Age 49 · 2212 by 1661 pixels · 30° FOV · undilated pupil · fundus photo — 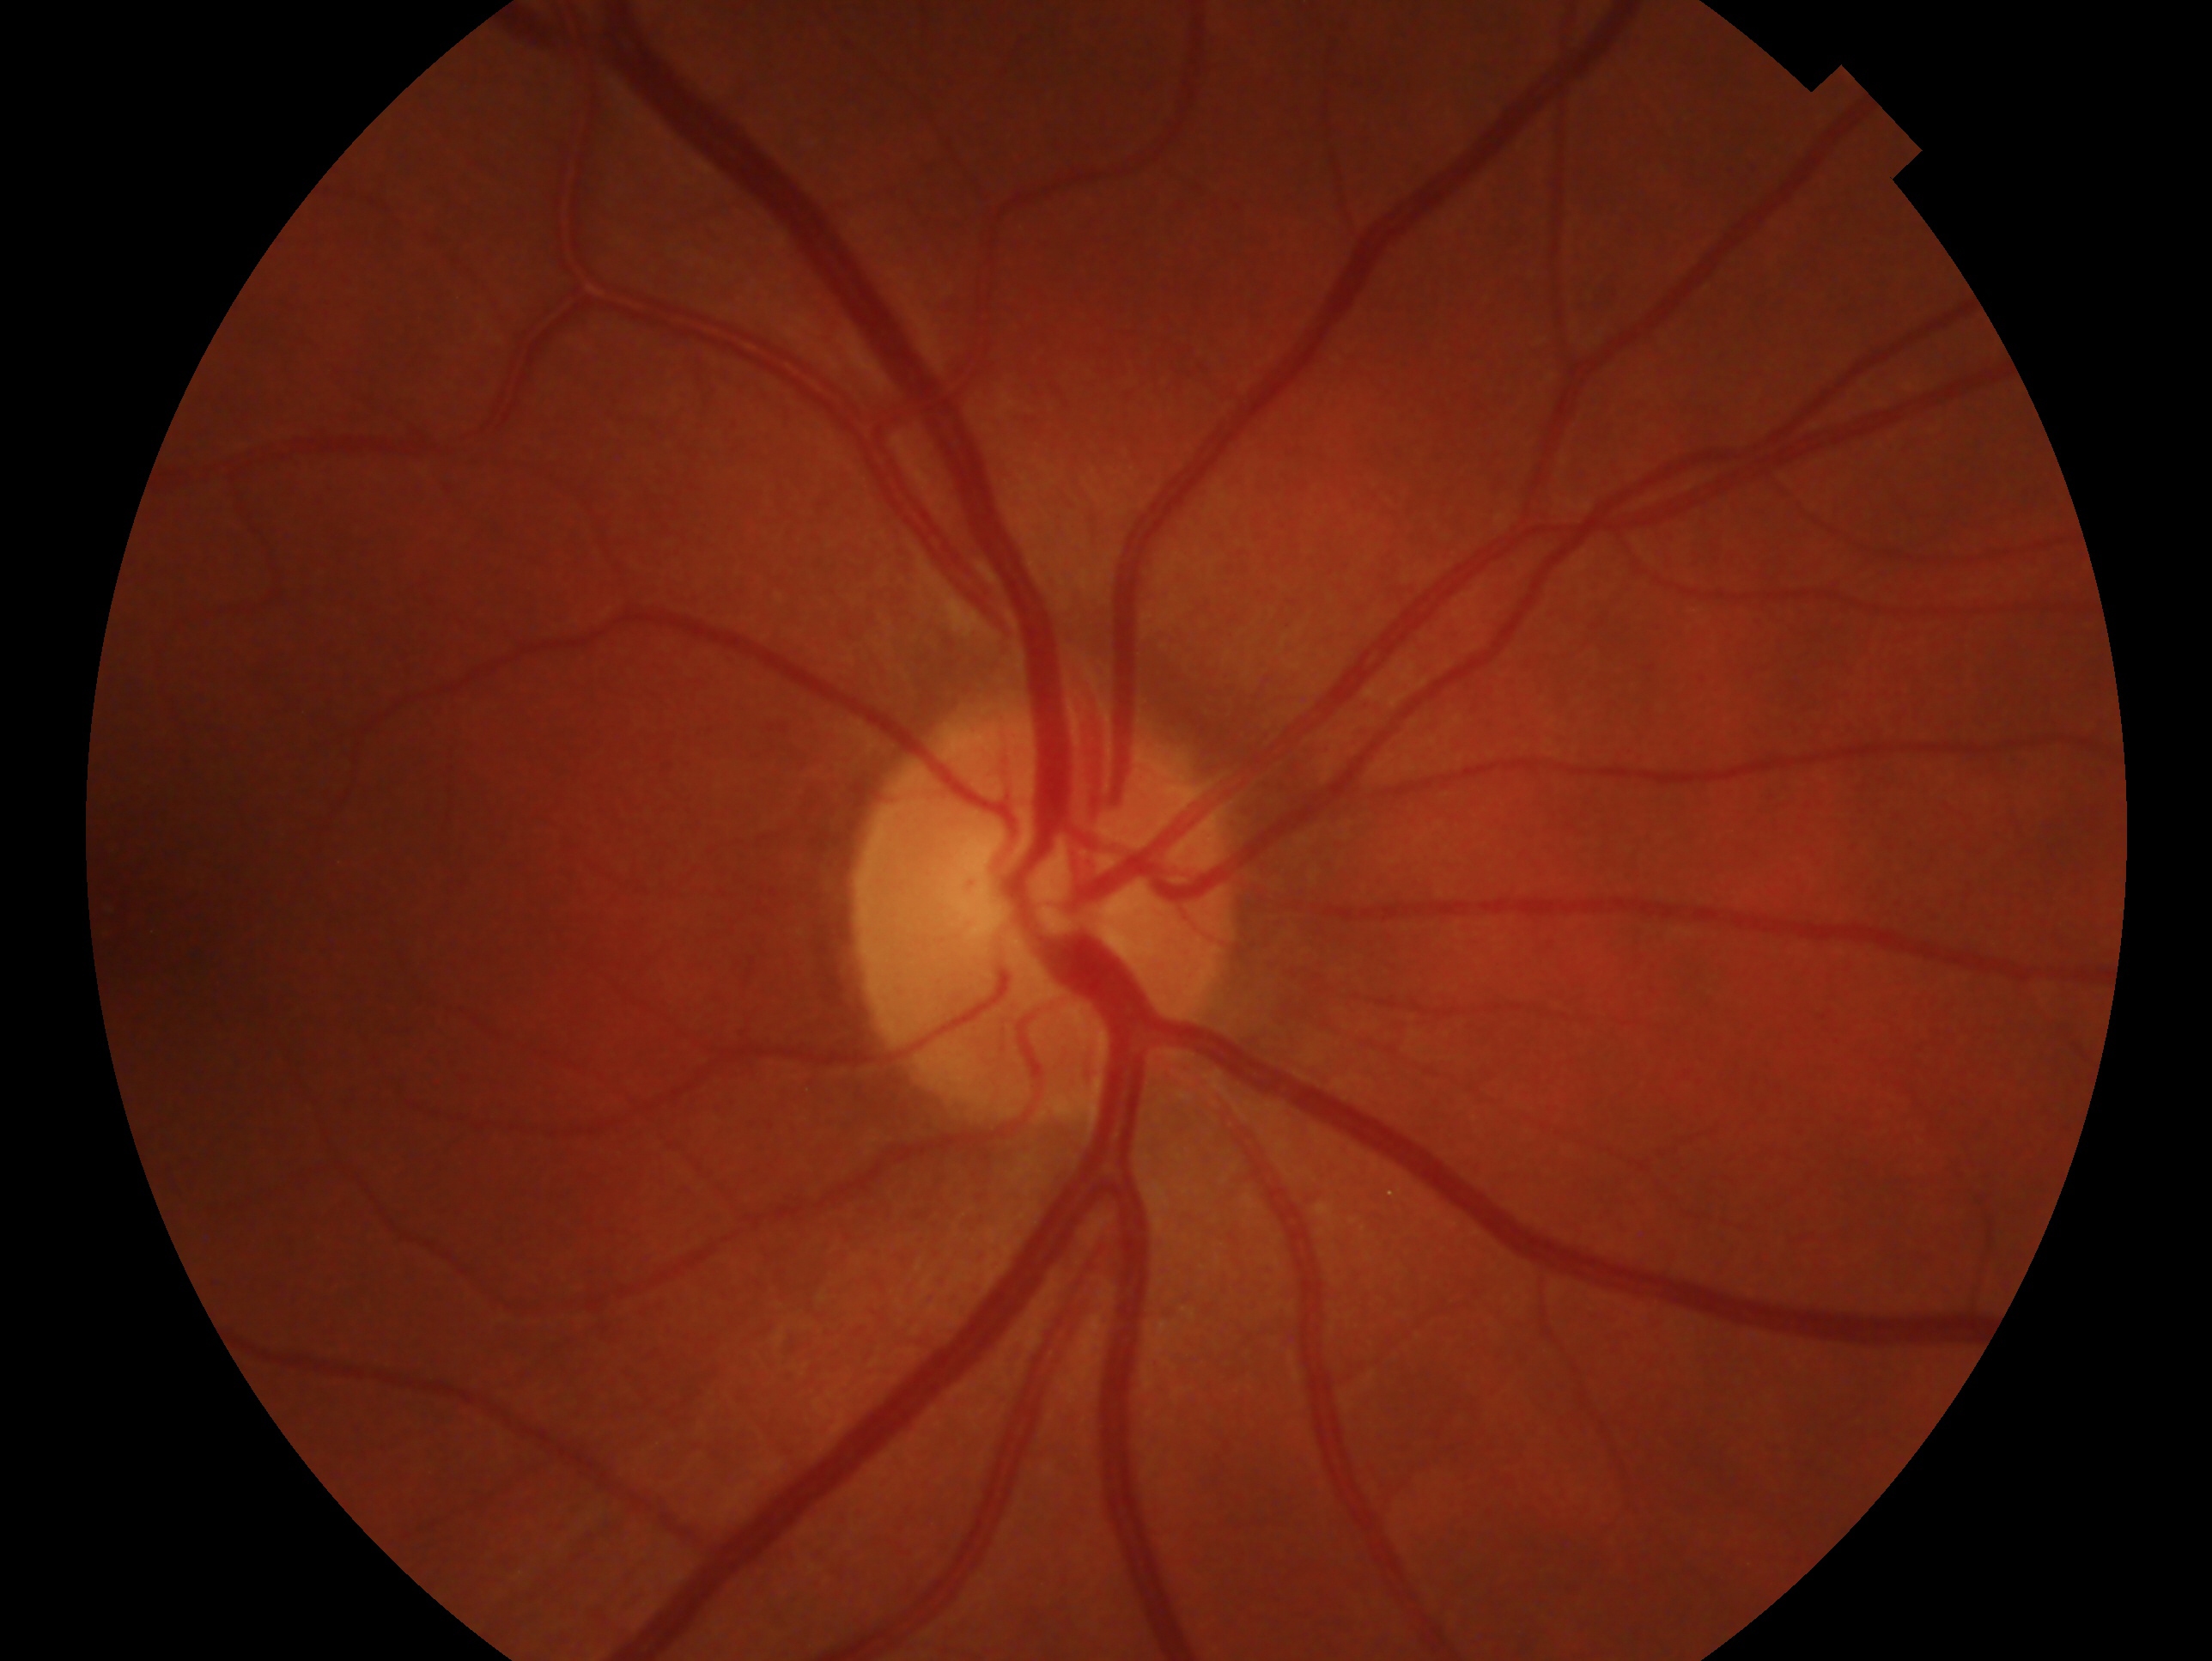 impression: no evidence of glaucoma
laterality: right